2352 x 1568 pixels, color fundus image — 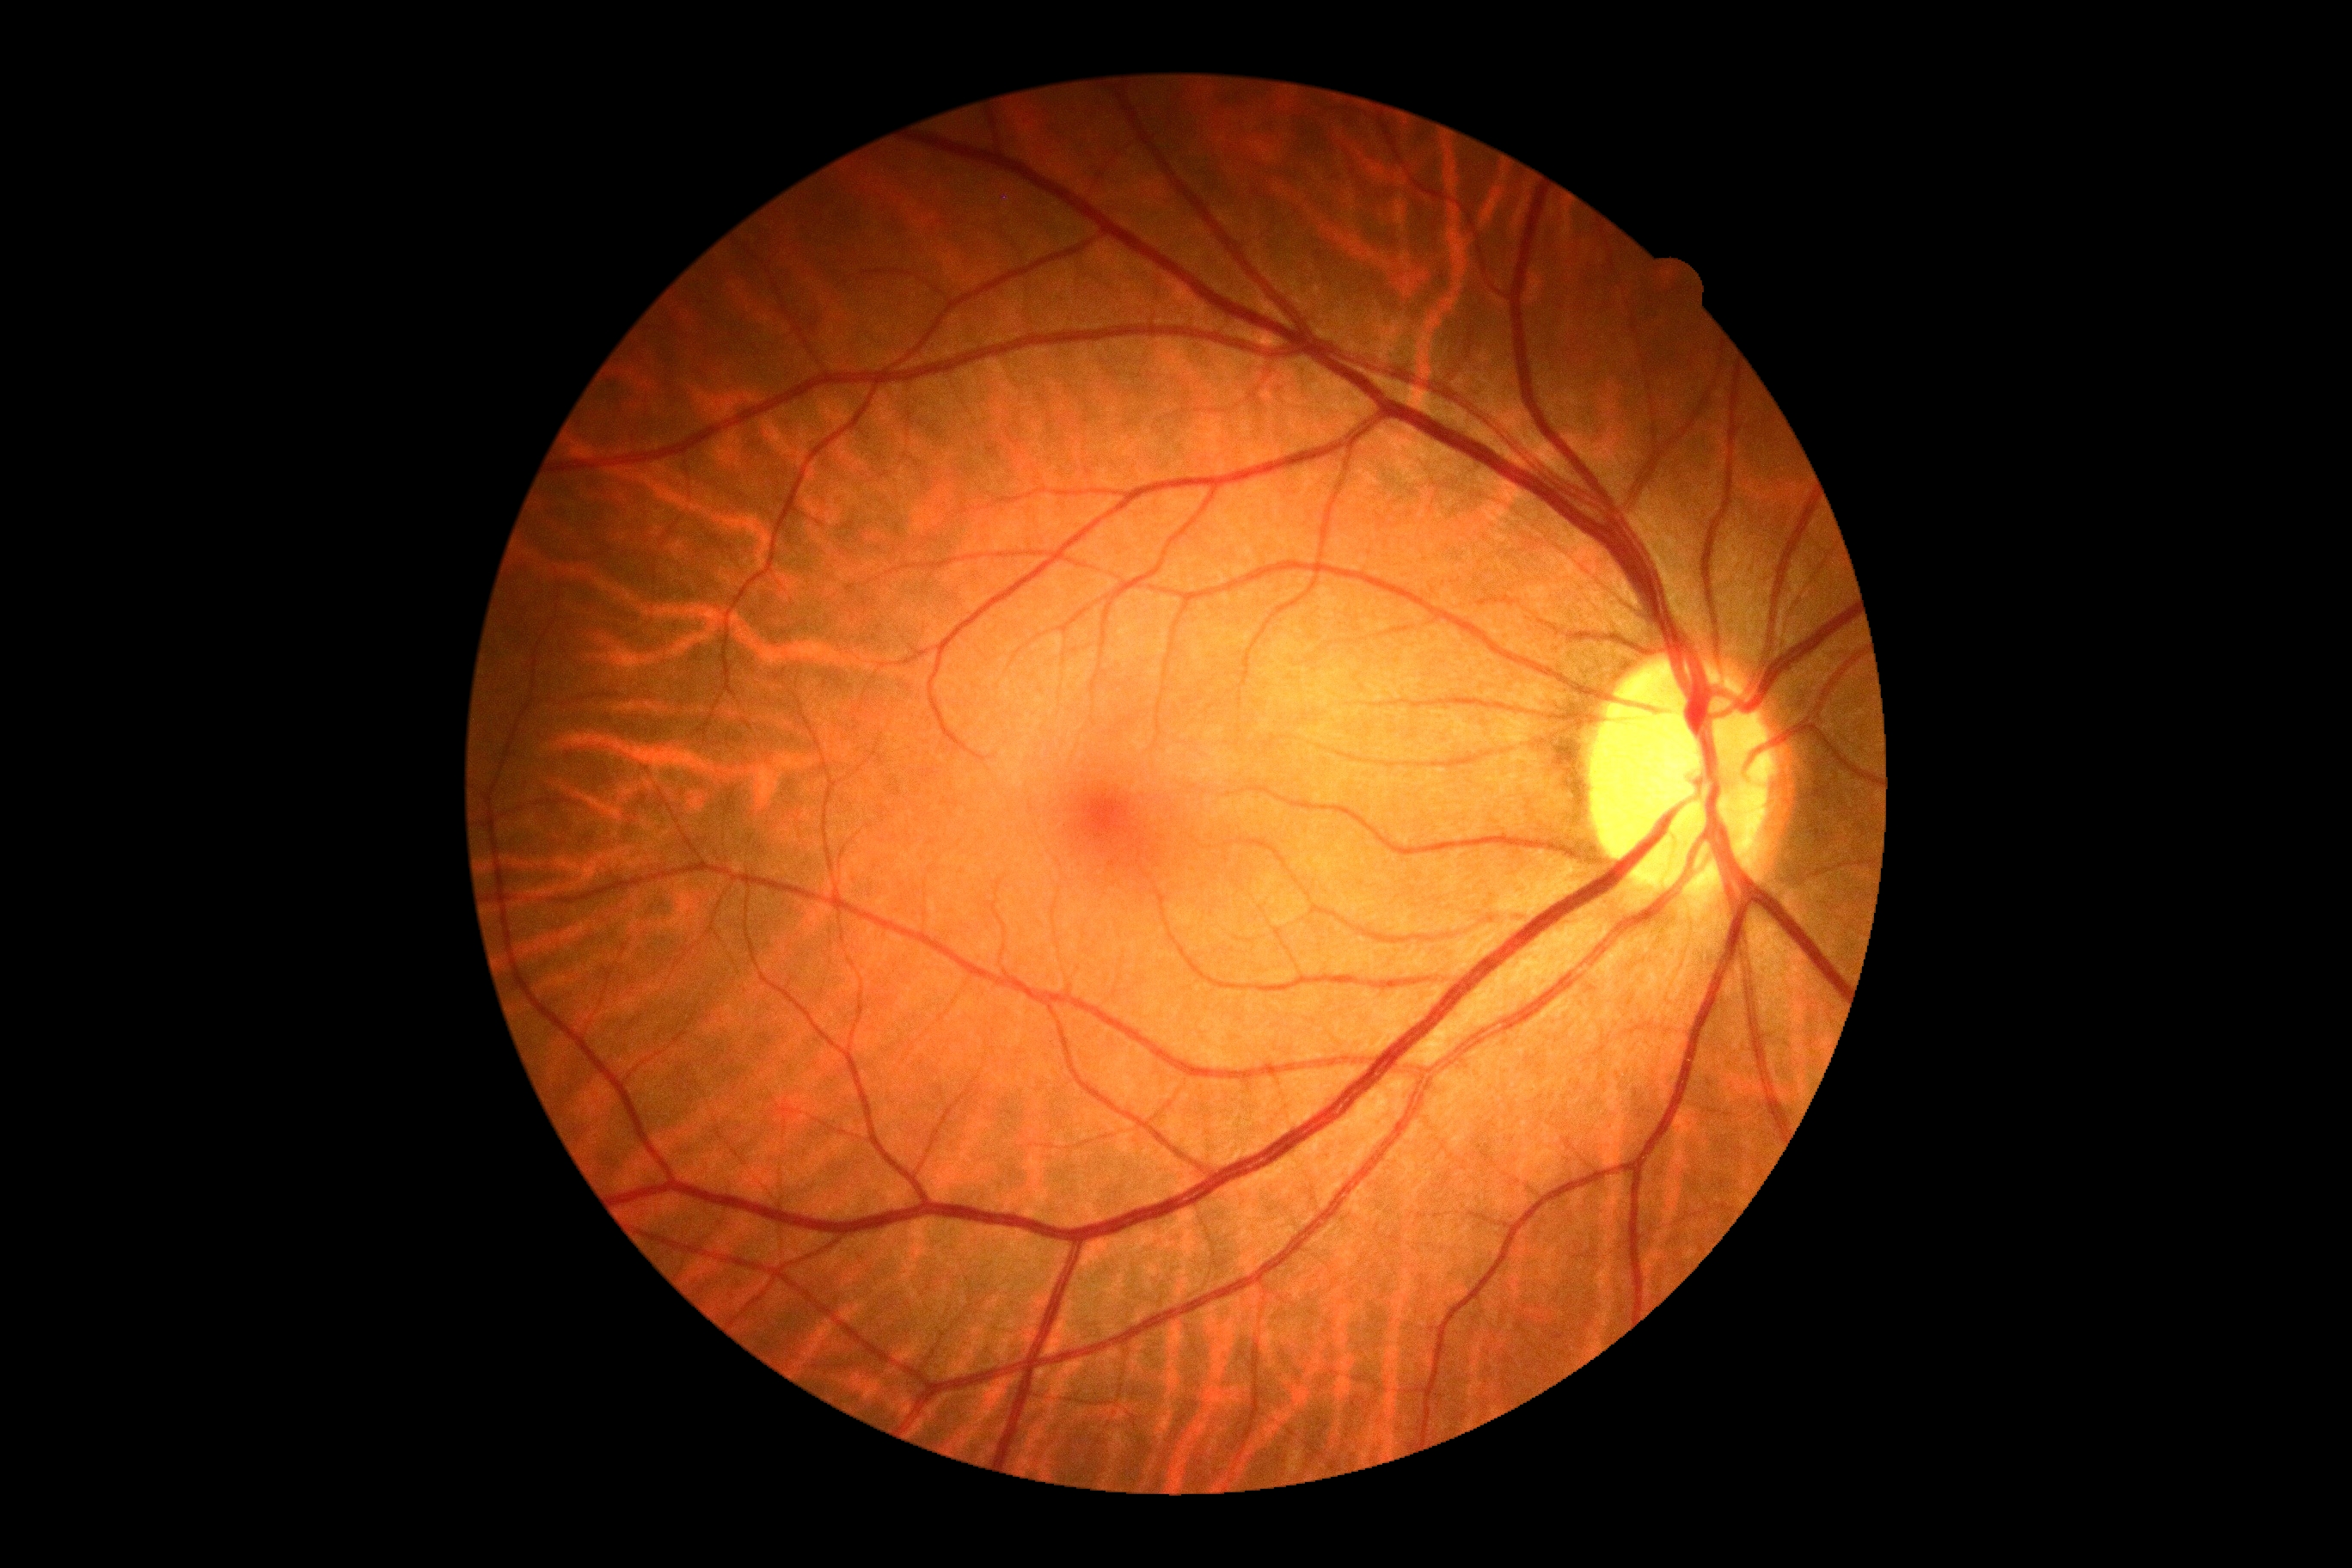 DR grade@0 (no apparent retinopathy).